Pediatric wide-field fundus photograph · image size 1240x1240 · acquired on the Phoenix ICON — 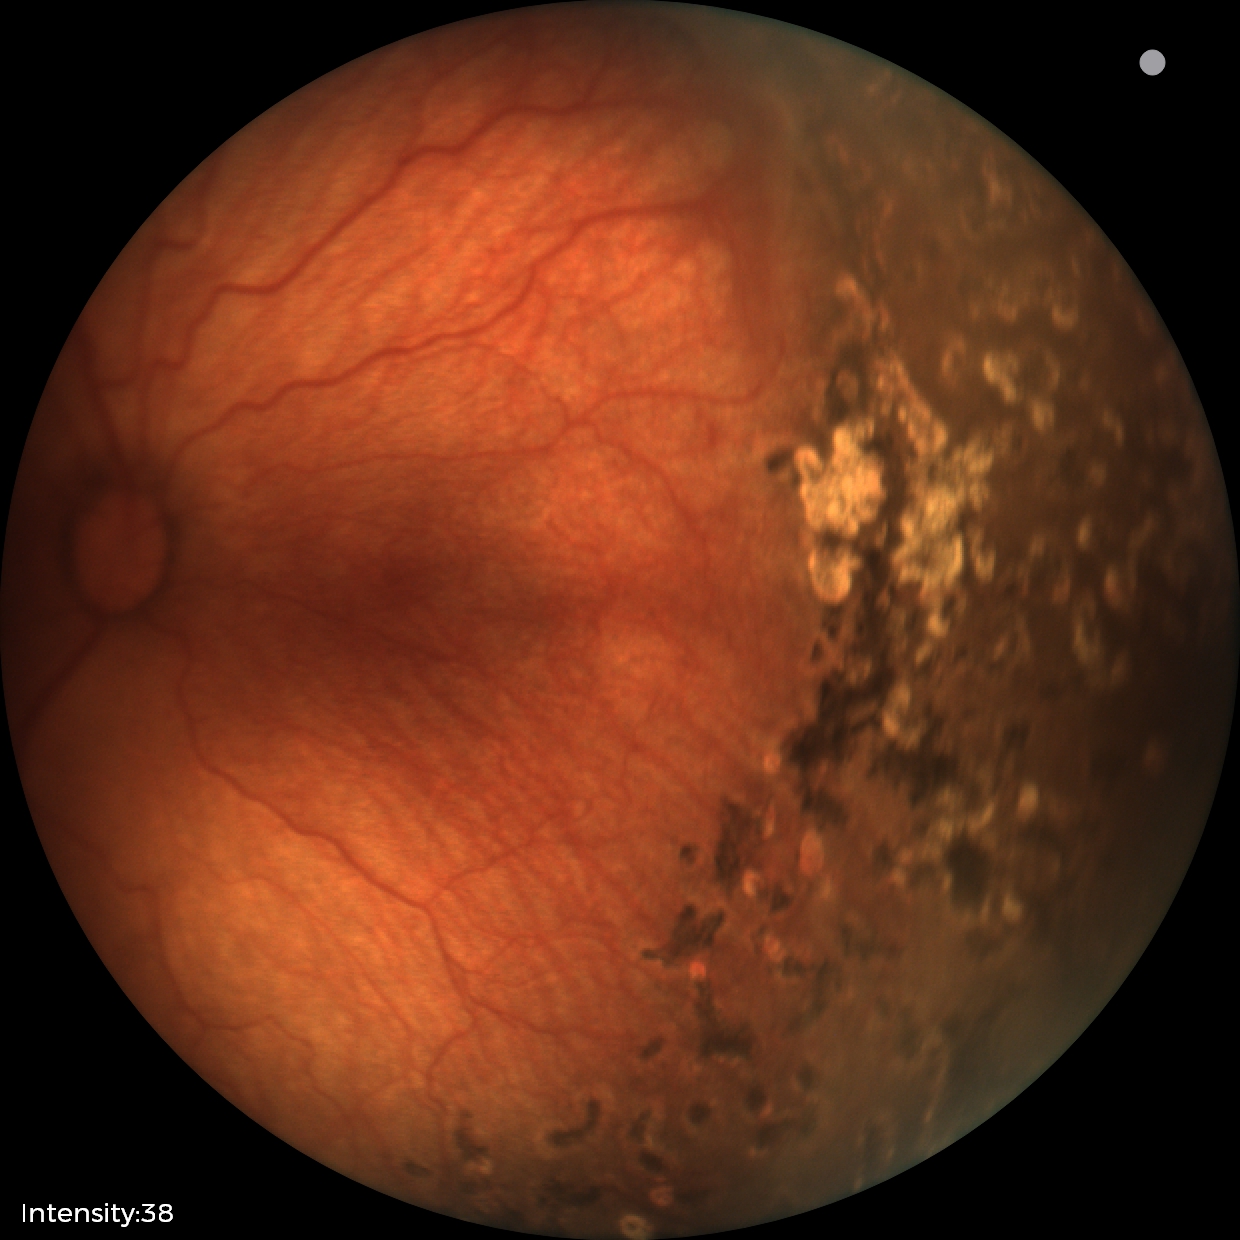
Screening examination consistent with status post ROP.